2352 by 1568 pixels. 45° FOV:
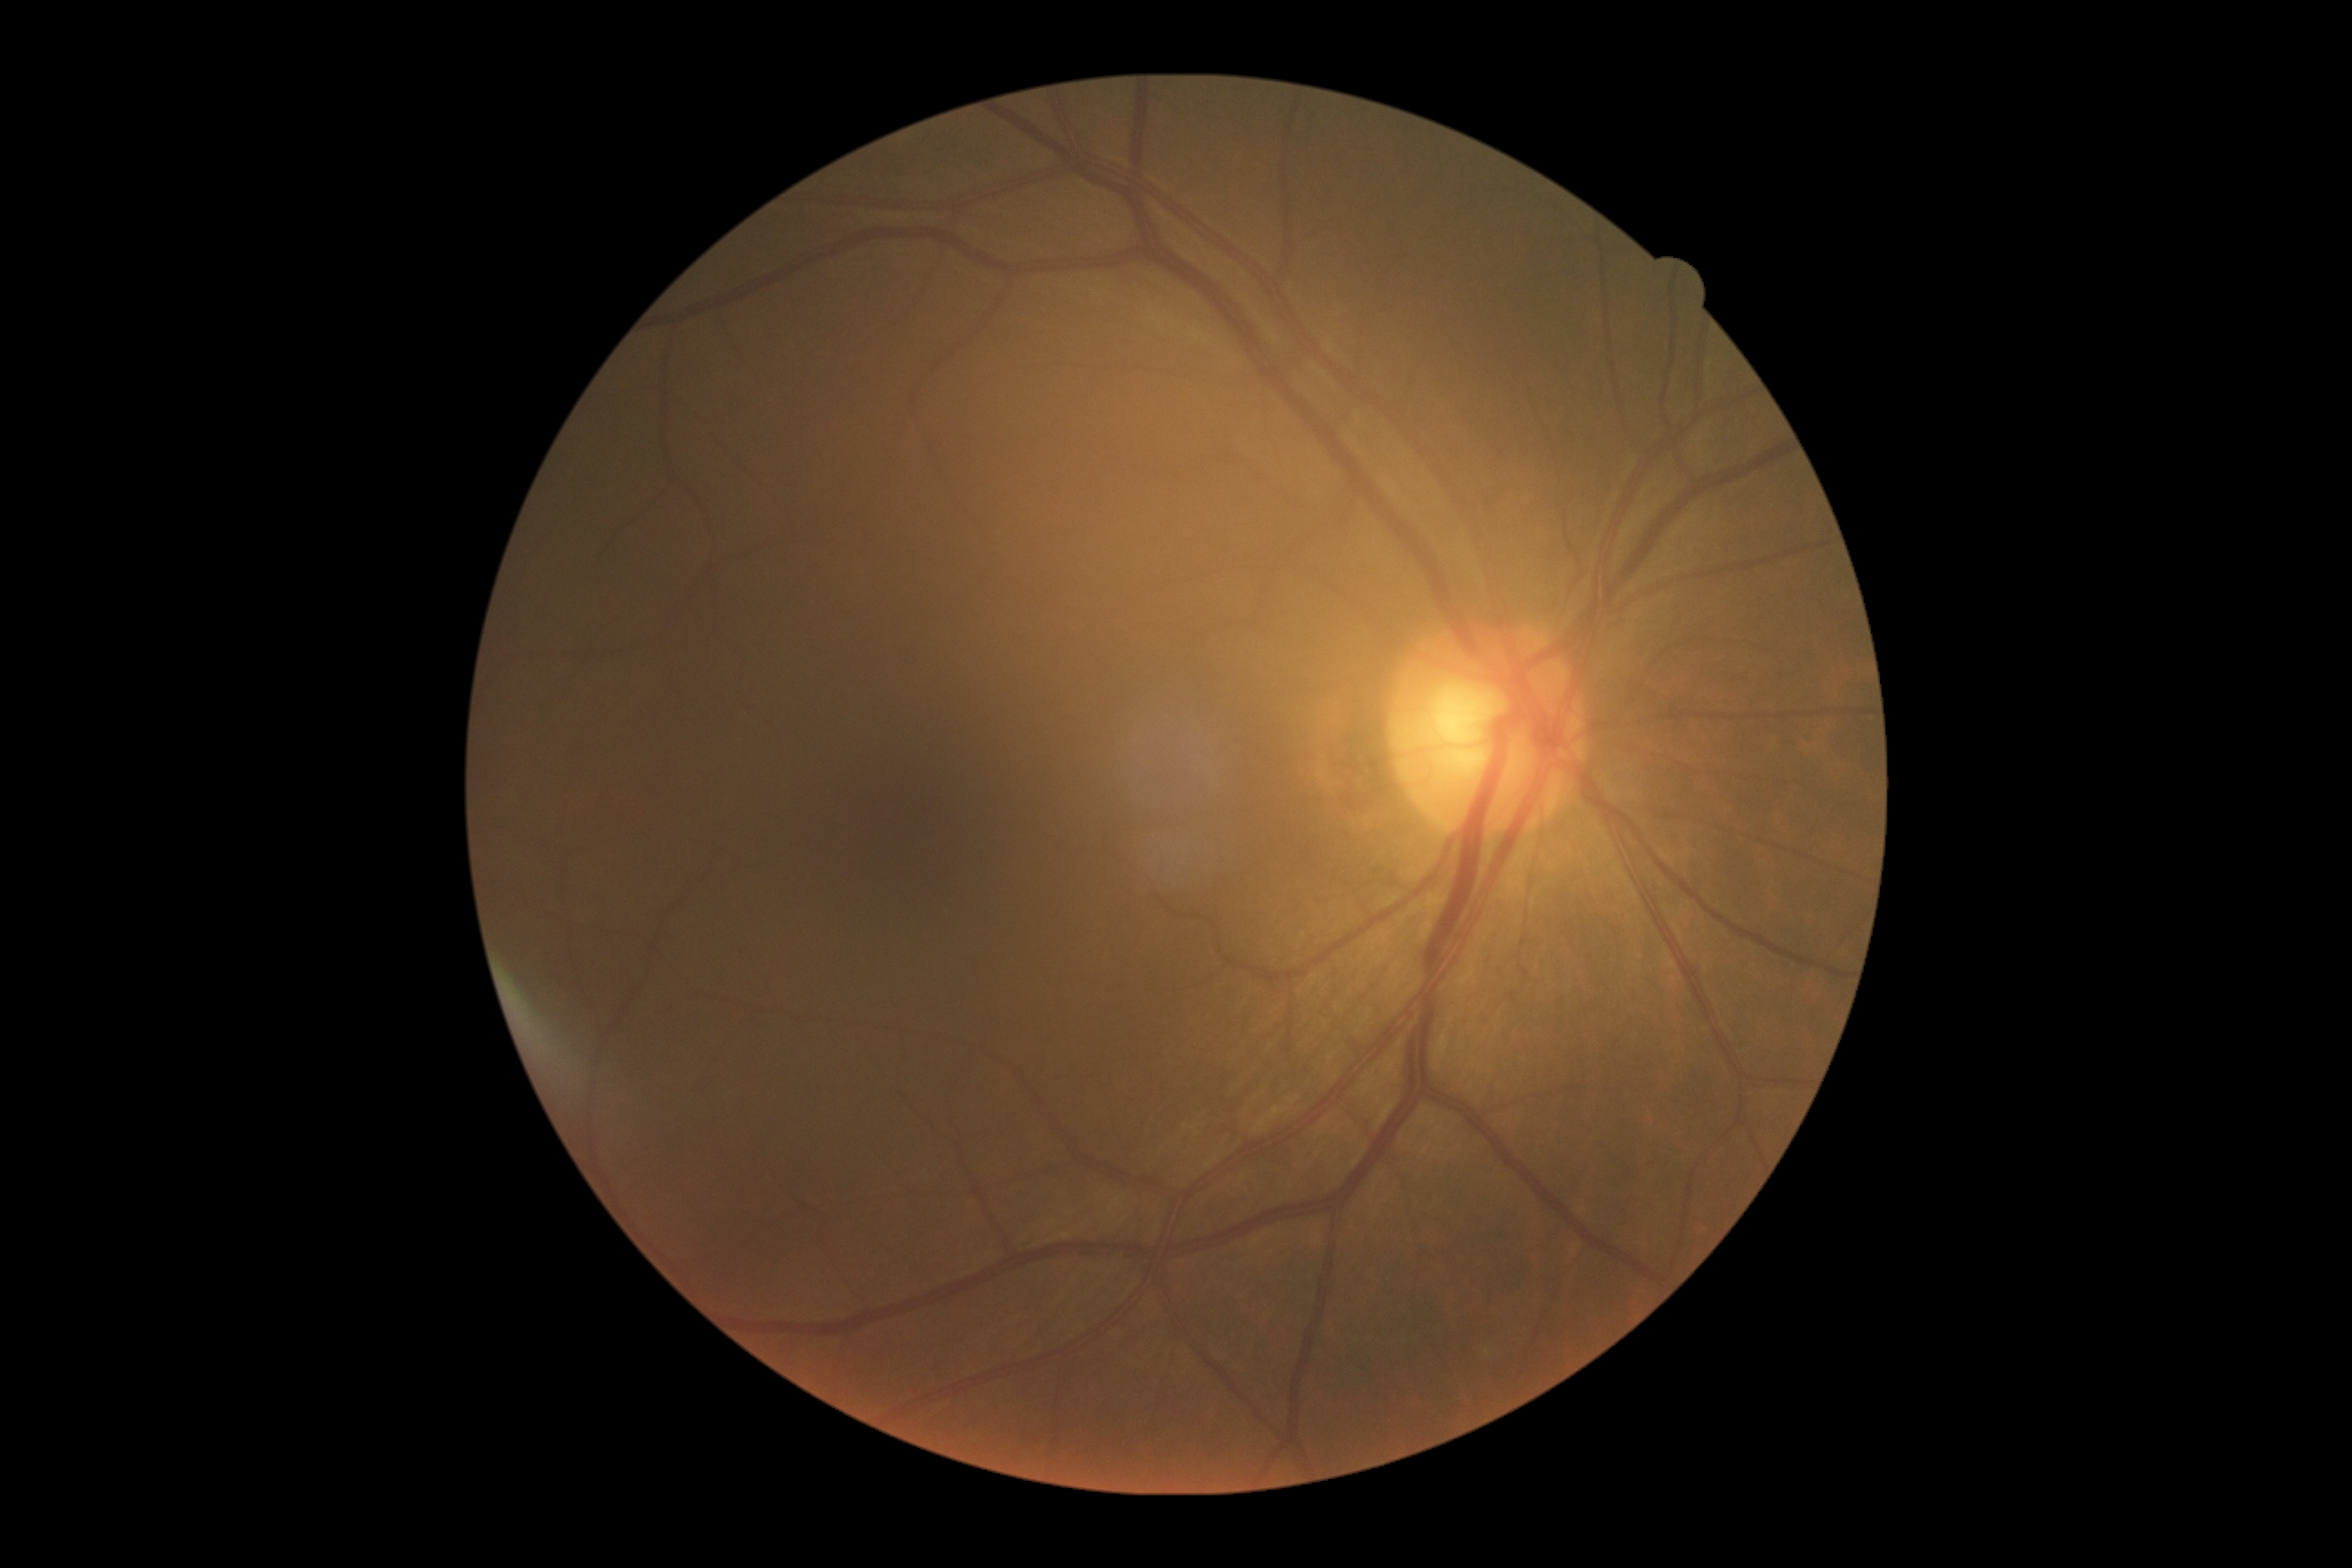
No diabetic retinal disease findings.
DR severity: grade 0 (no apparent retinopathy) — no visible signs of diabetic retinopathy.